Image size 1932x1932: 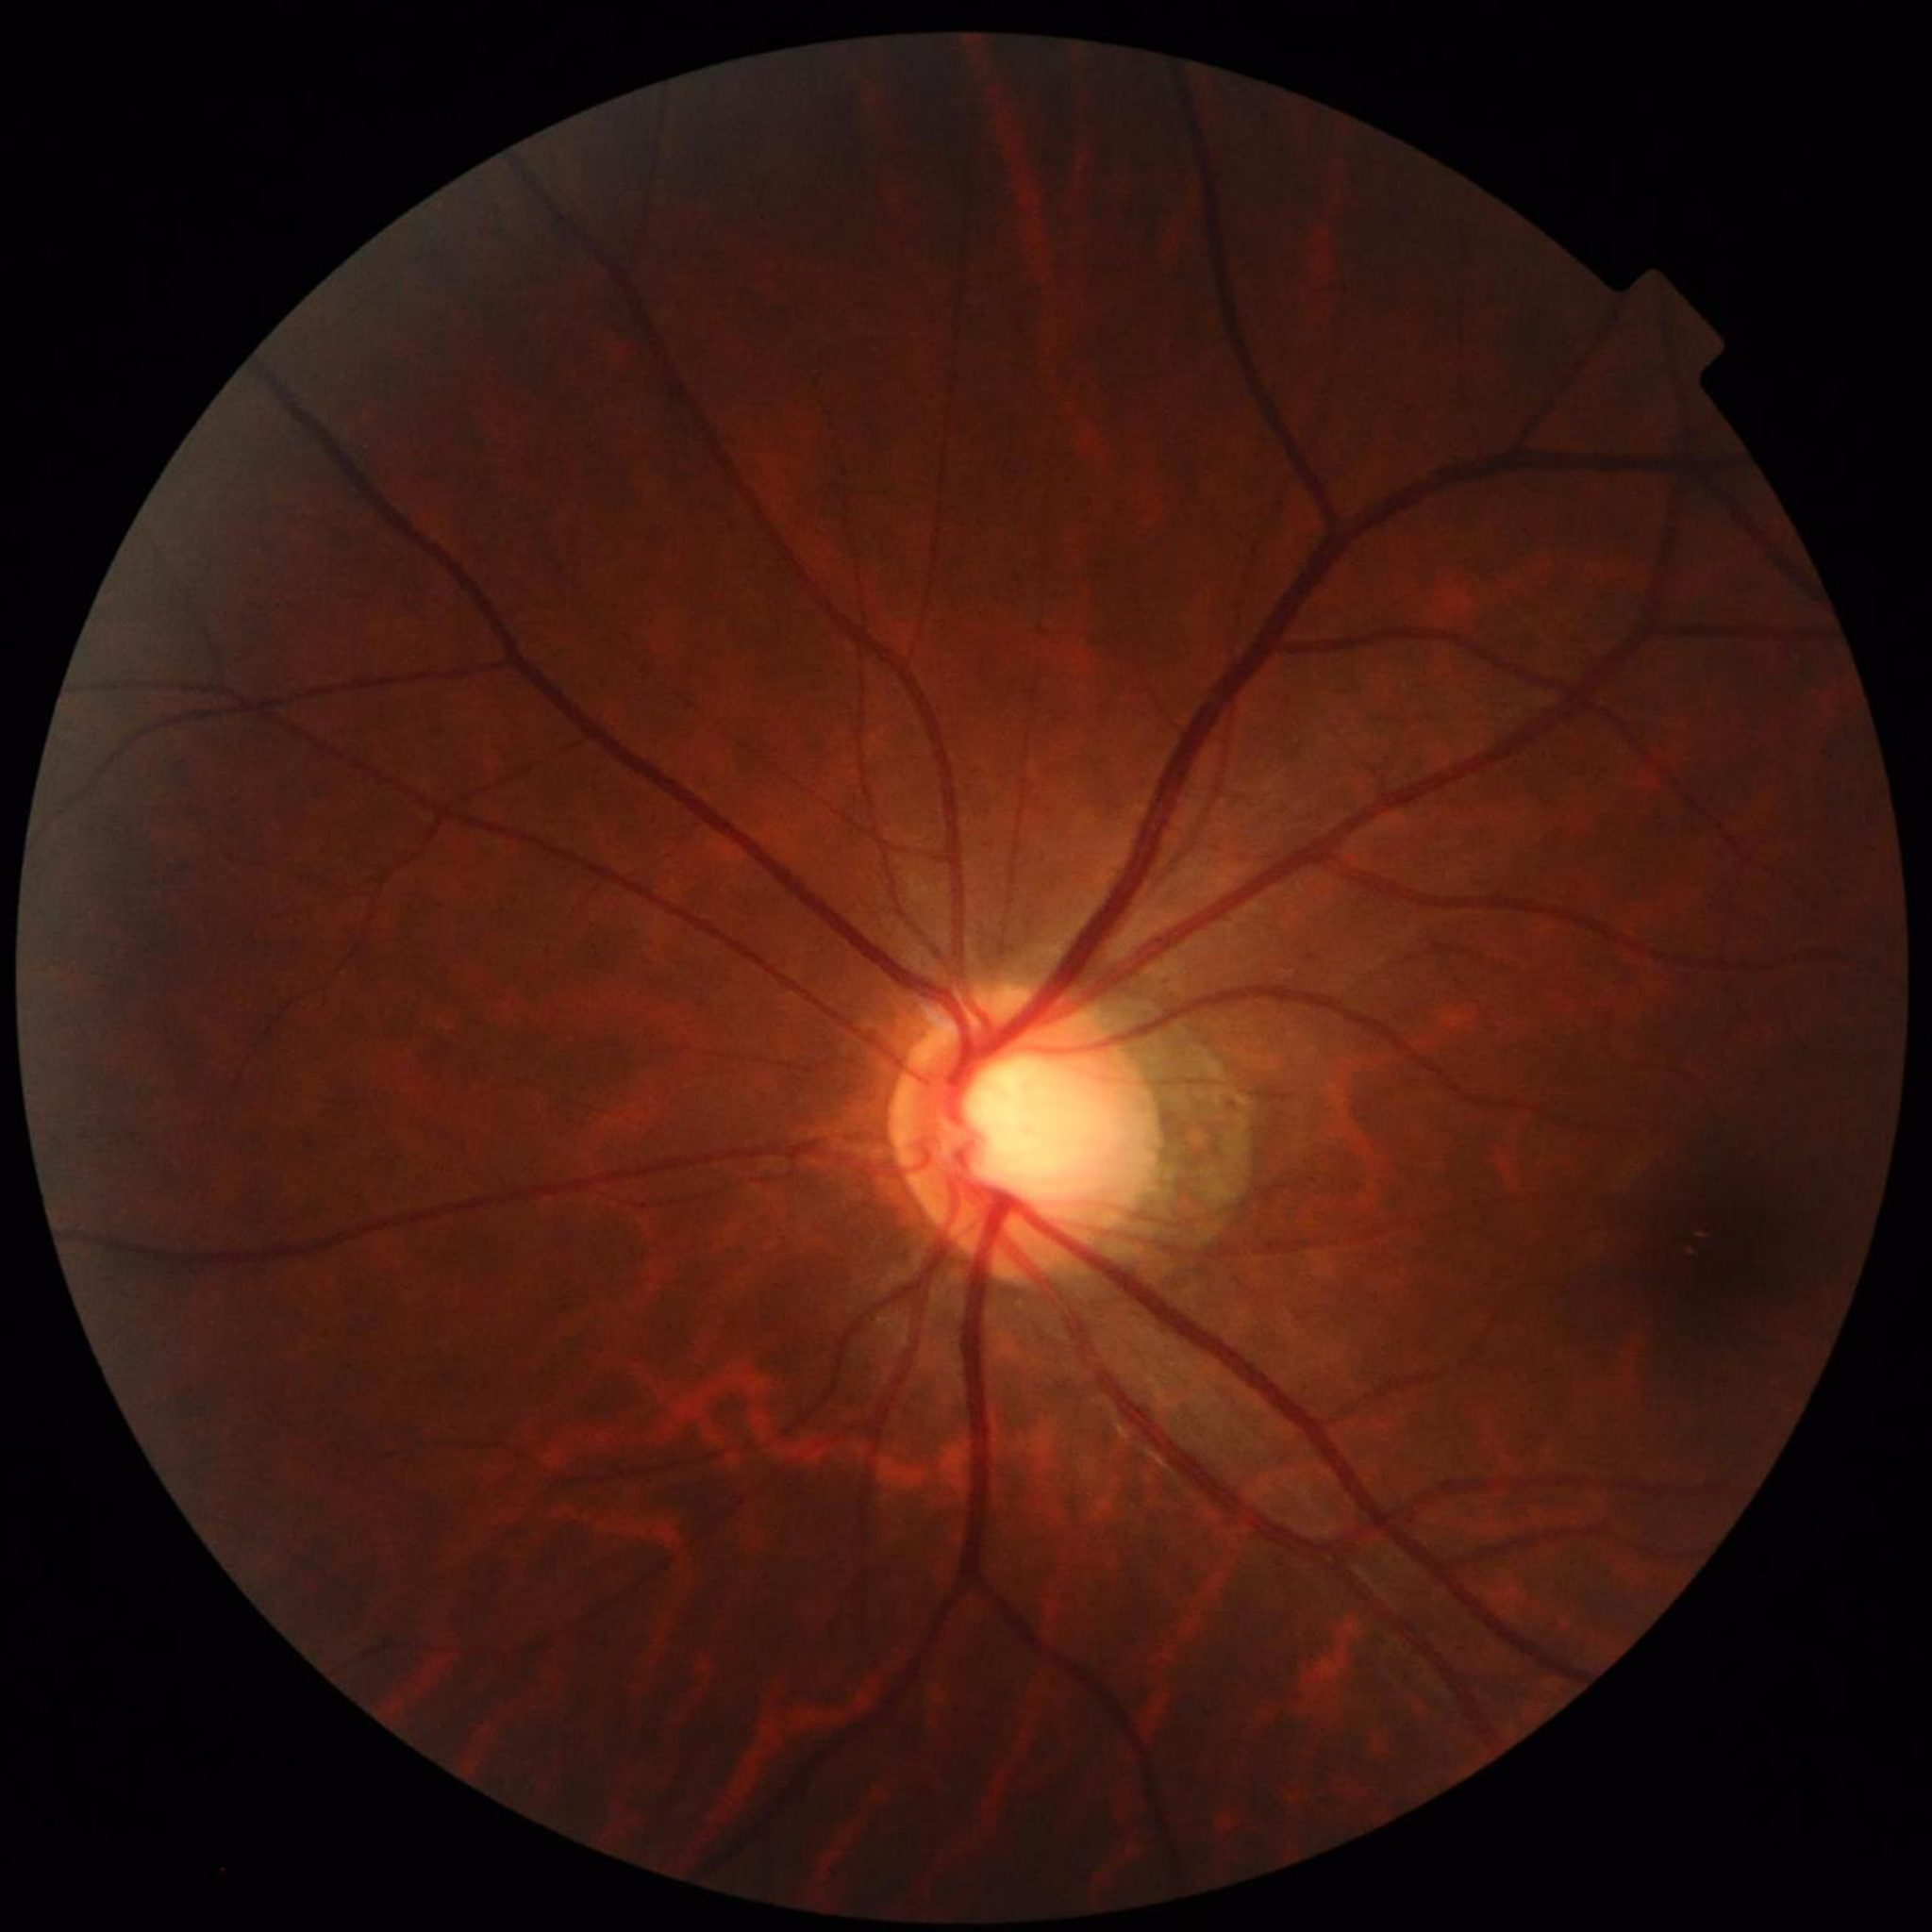
Impression: glaucoma.